Color fundus image · nonmydriatic · 848 x 848 pixels · modified Davis grading · camera: NIDEK AFC-230 — 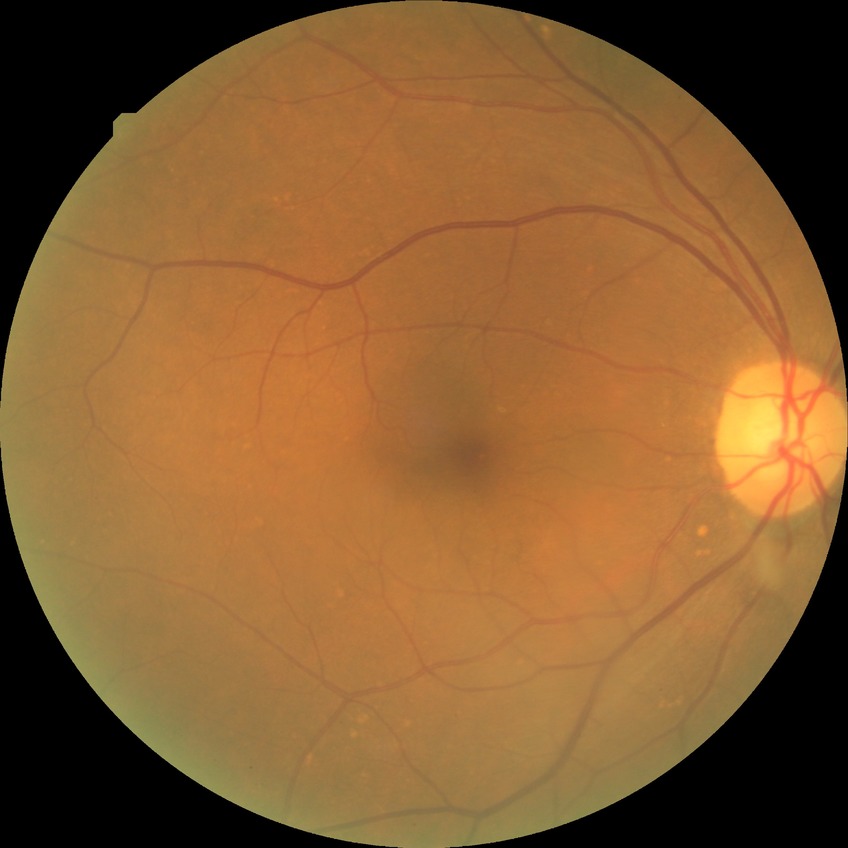
Davis grading: no diabetic retinopathy.